2048x1536px, fundus photo.
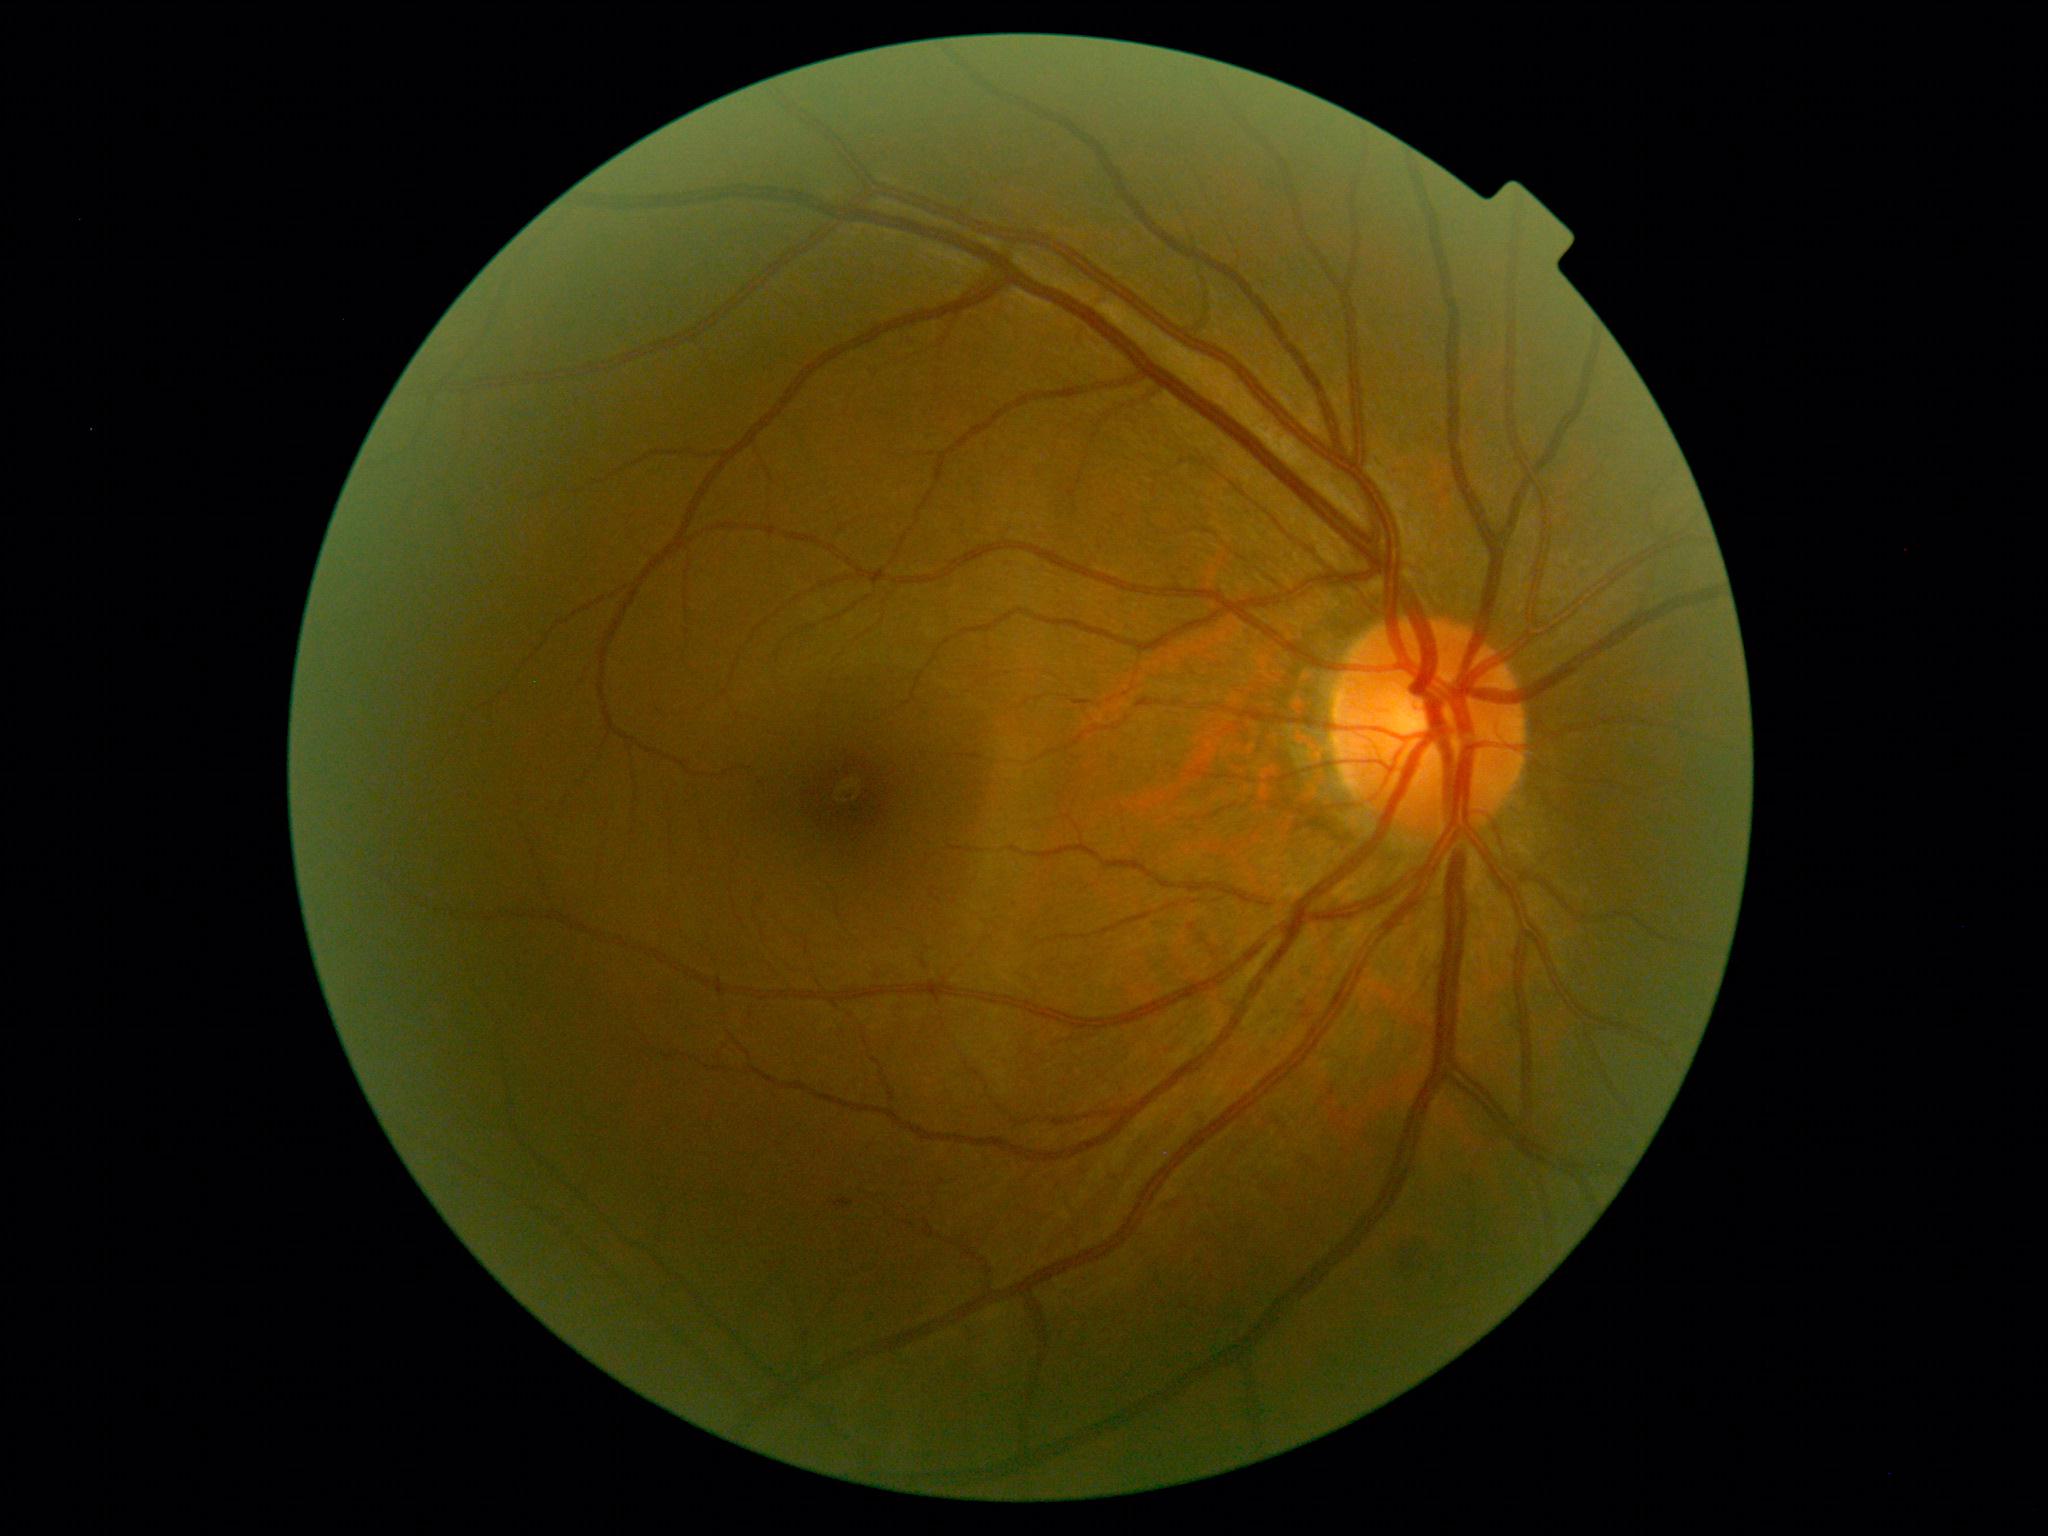
• DR stage: grade 2 (moderate NPDR) — more than just microaneurysms but less than severe NPDR